Image size 1440x1080. Wide-field fundus photograph from neonatal ROP screening. Acquired on the Natus RetCam Envision:
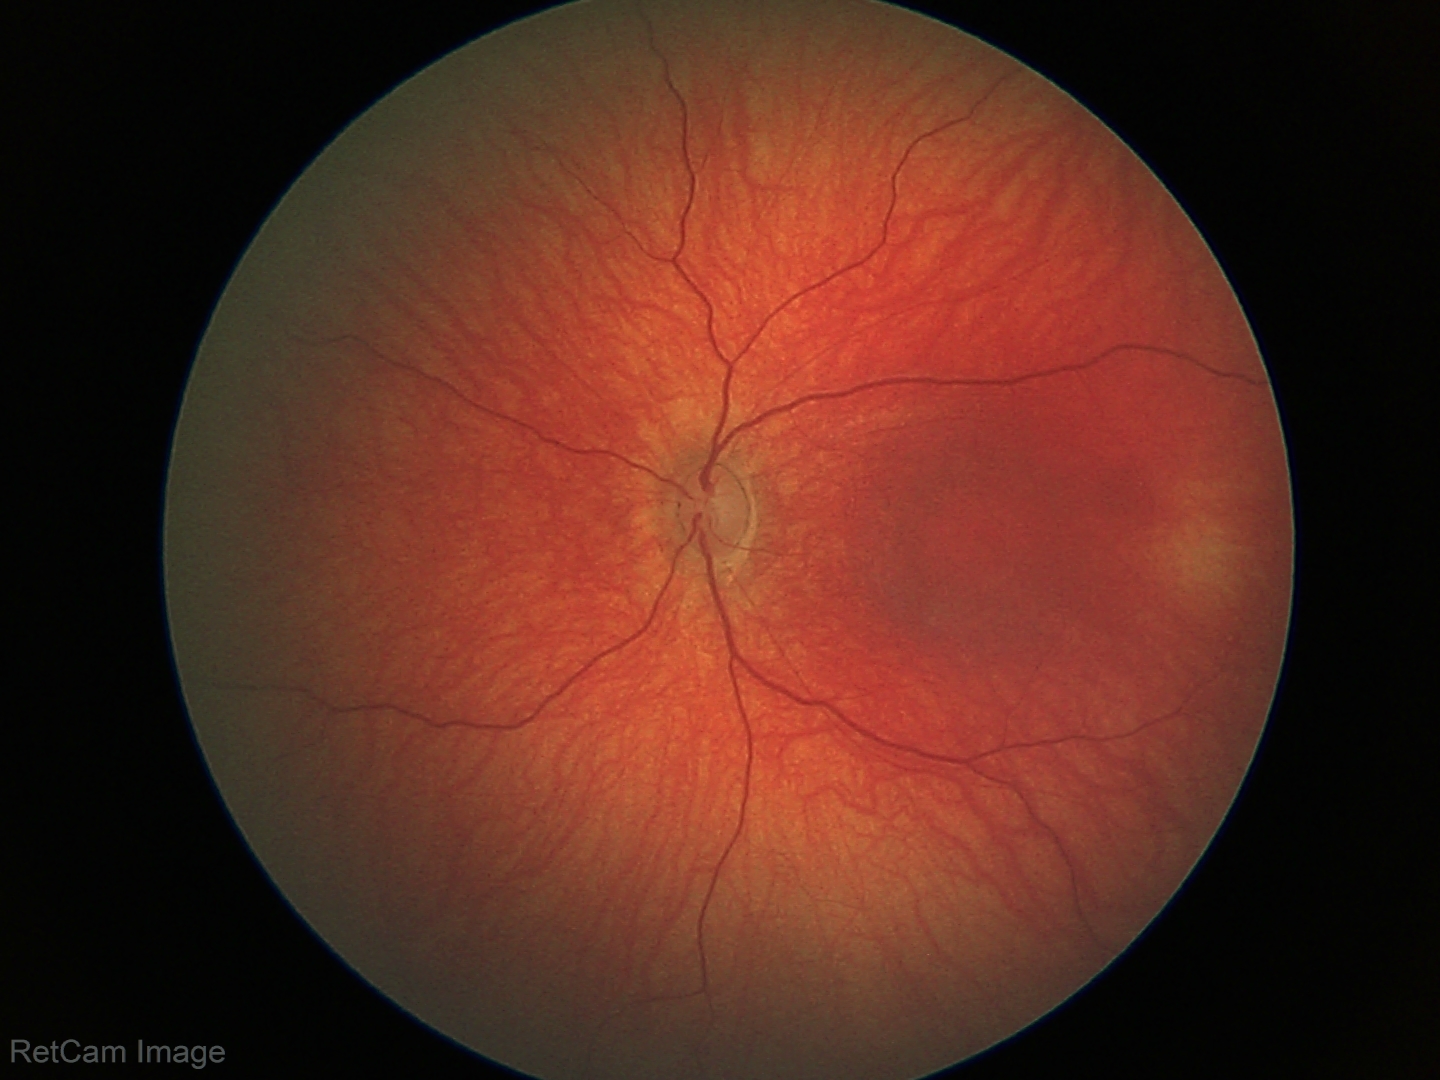

Screening diagnosis: physiological appearance.